Acquired with a NIDEK AFC-230 · graded on the modified Davis scale · 45 degree fundus photograph: 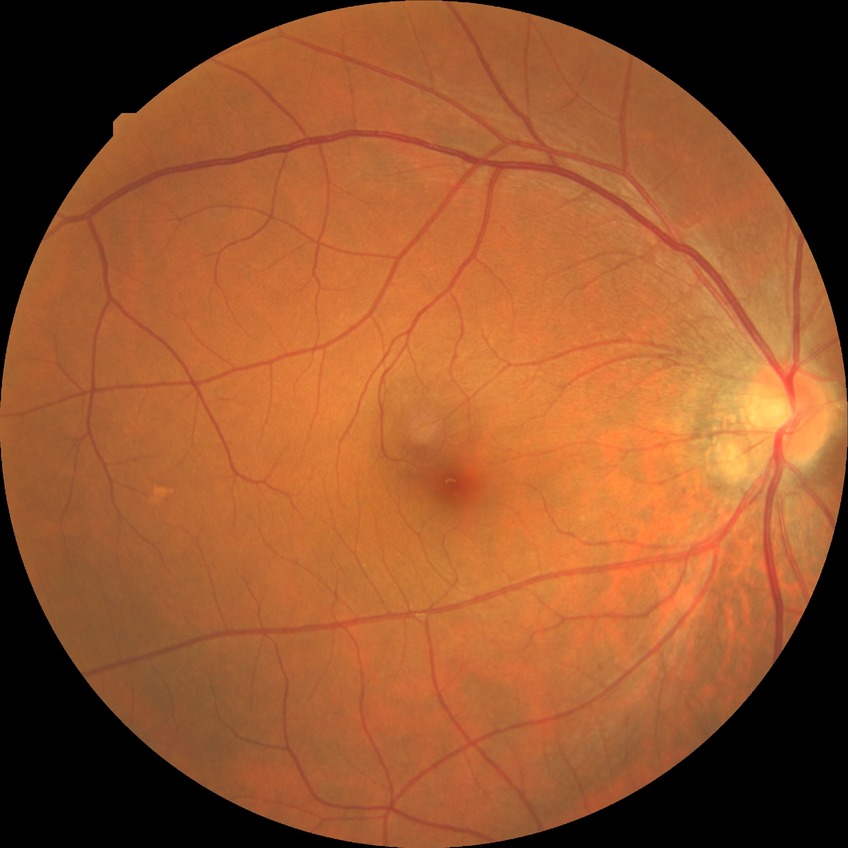
diabetic retinopathy (DR): NDR (no diabetic retinopathy)